Ultra-widefield (UWF) fundus image
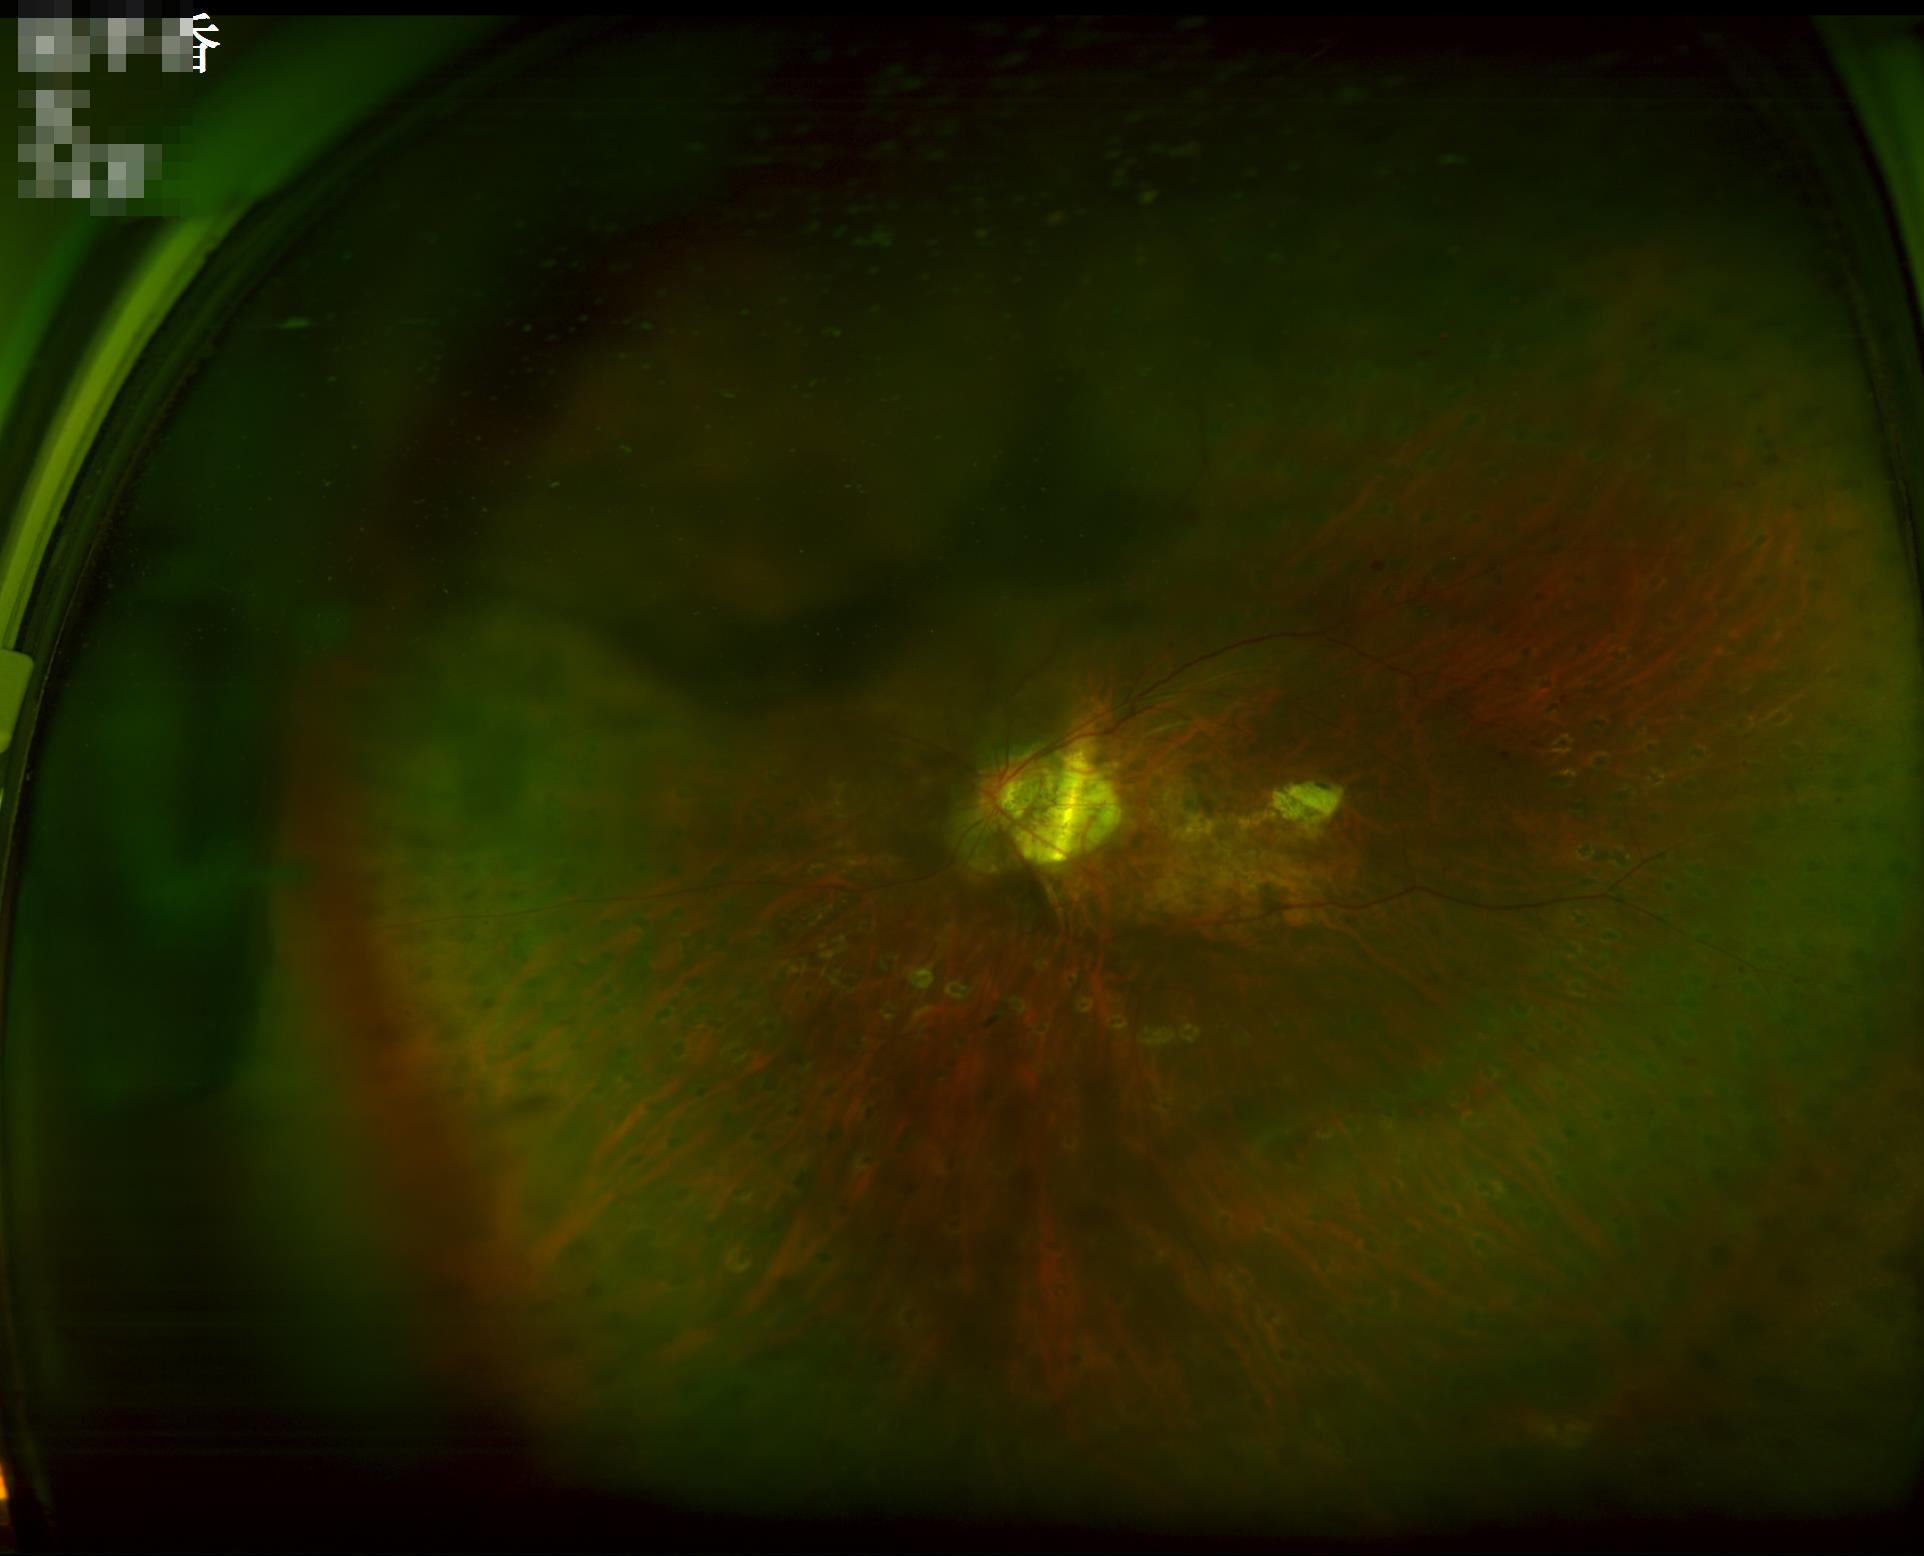 Poor dynamic range. Out of focus; structures are indistinct. Image quality is inadequate for diagnostic use. Poor illumination with uneven exposure.